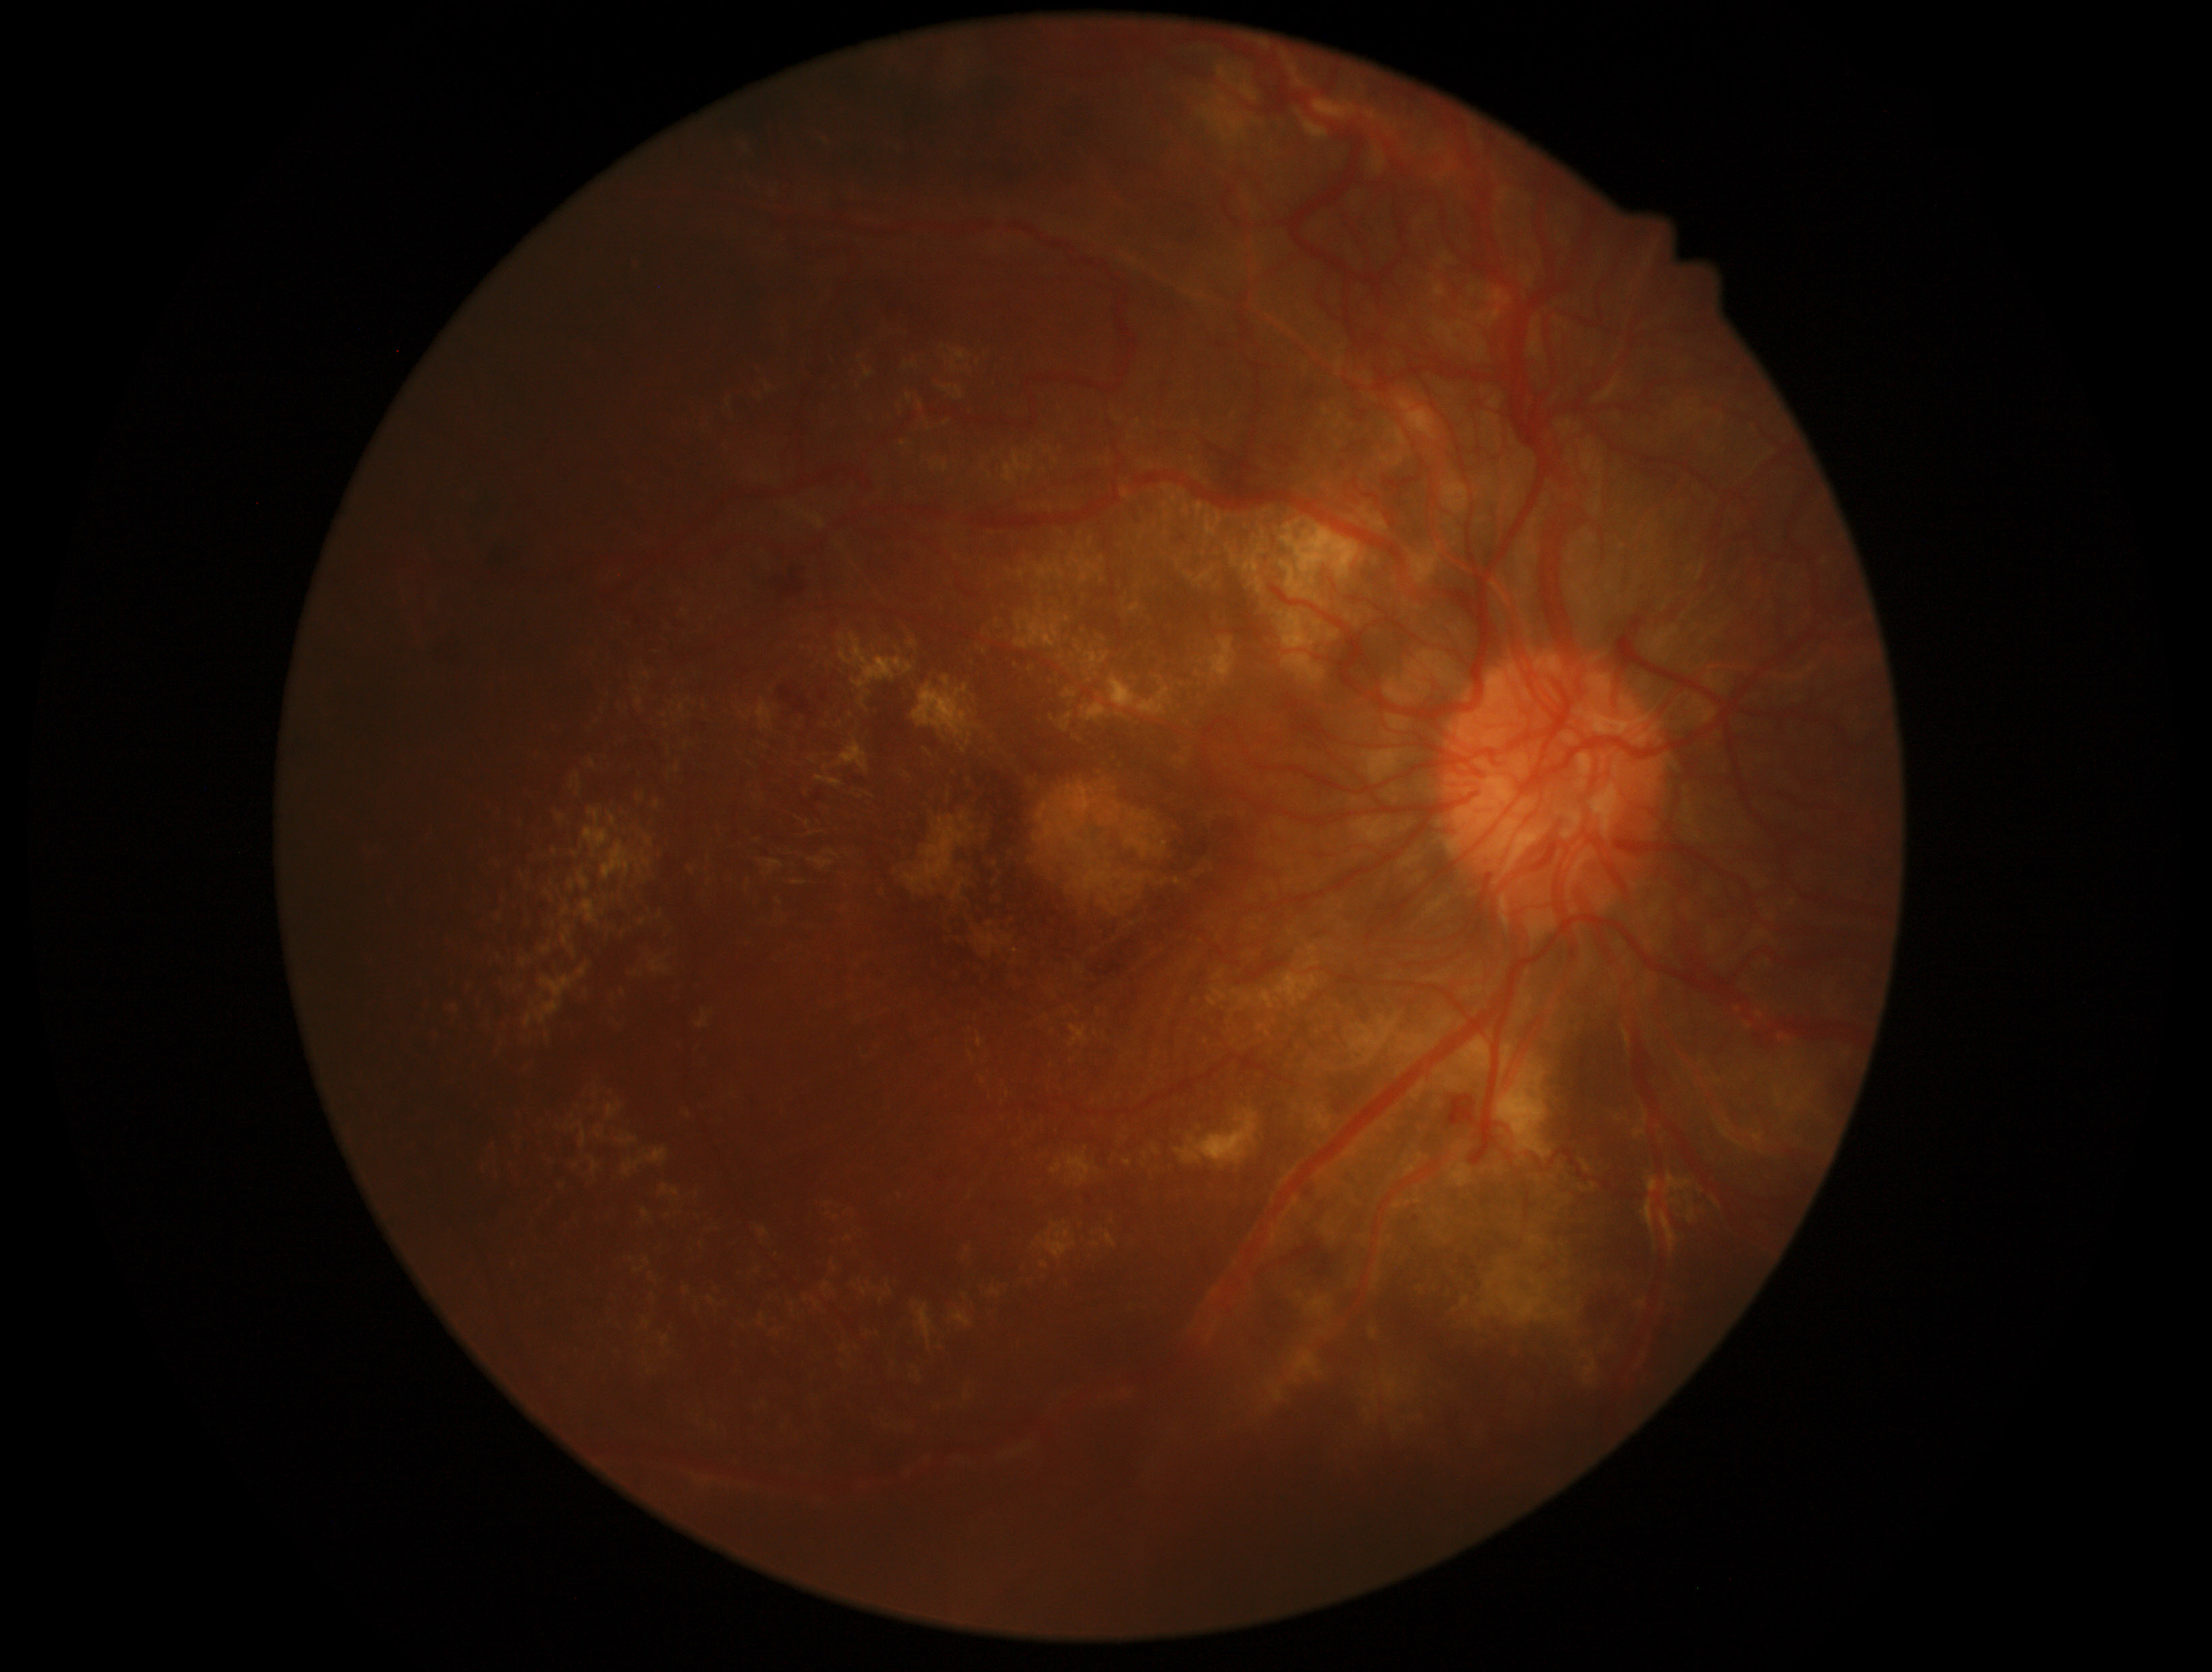

DR grade is 4/4.